Wide-field fundus image from infant ROP screening.
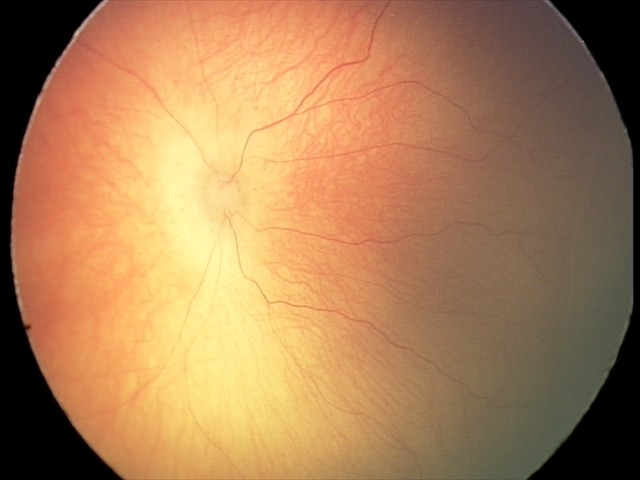

Assessment: retinopathy of prematurity stage 1 — demarcation line between vascular and avascular retina | no plus disease.